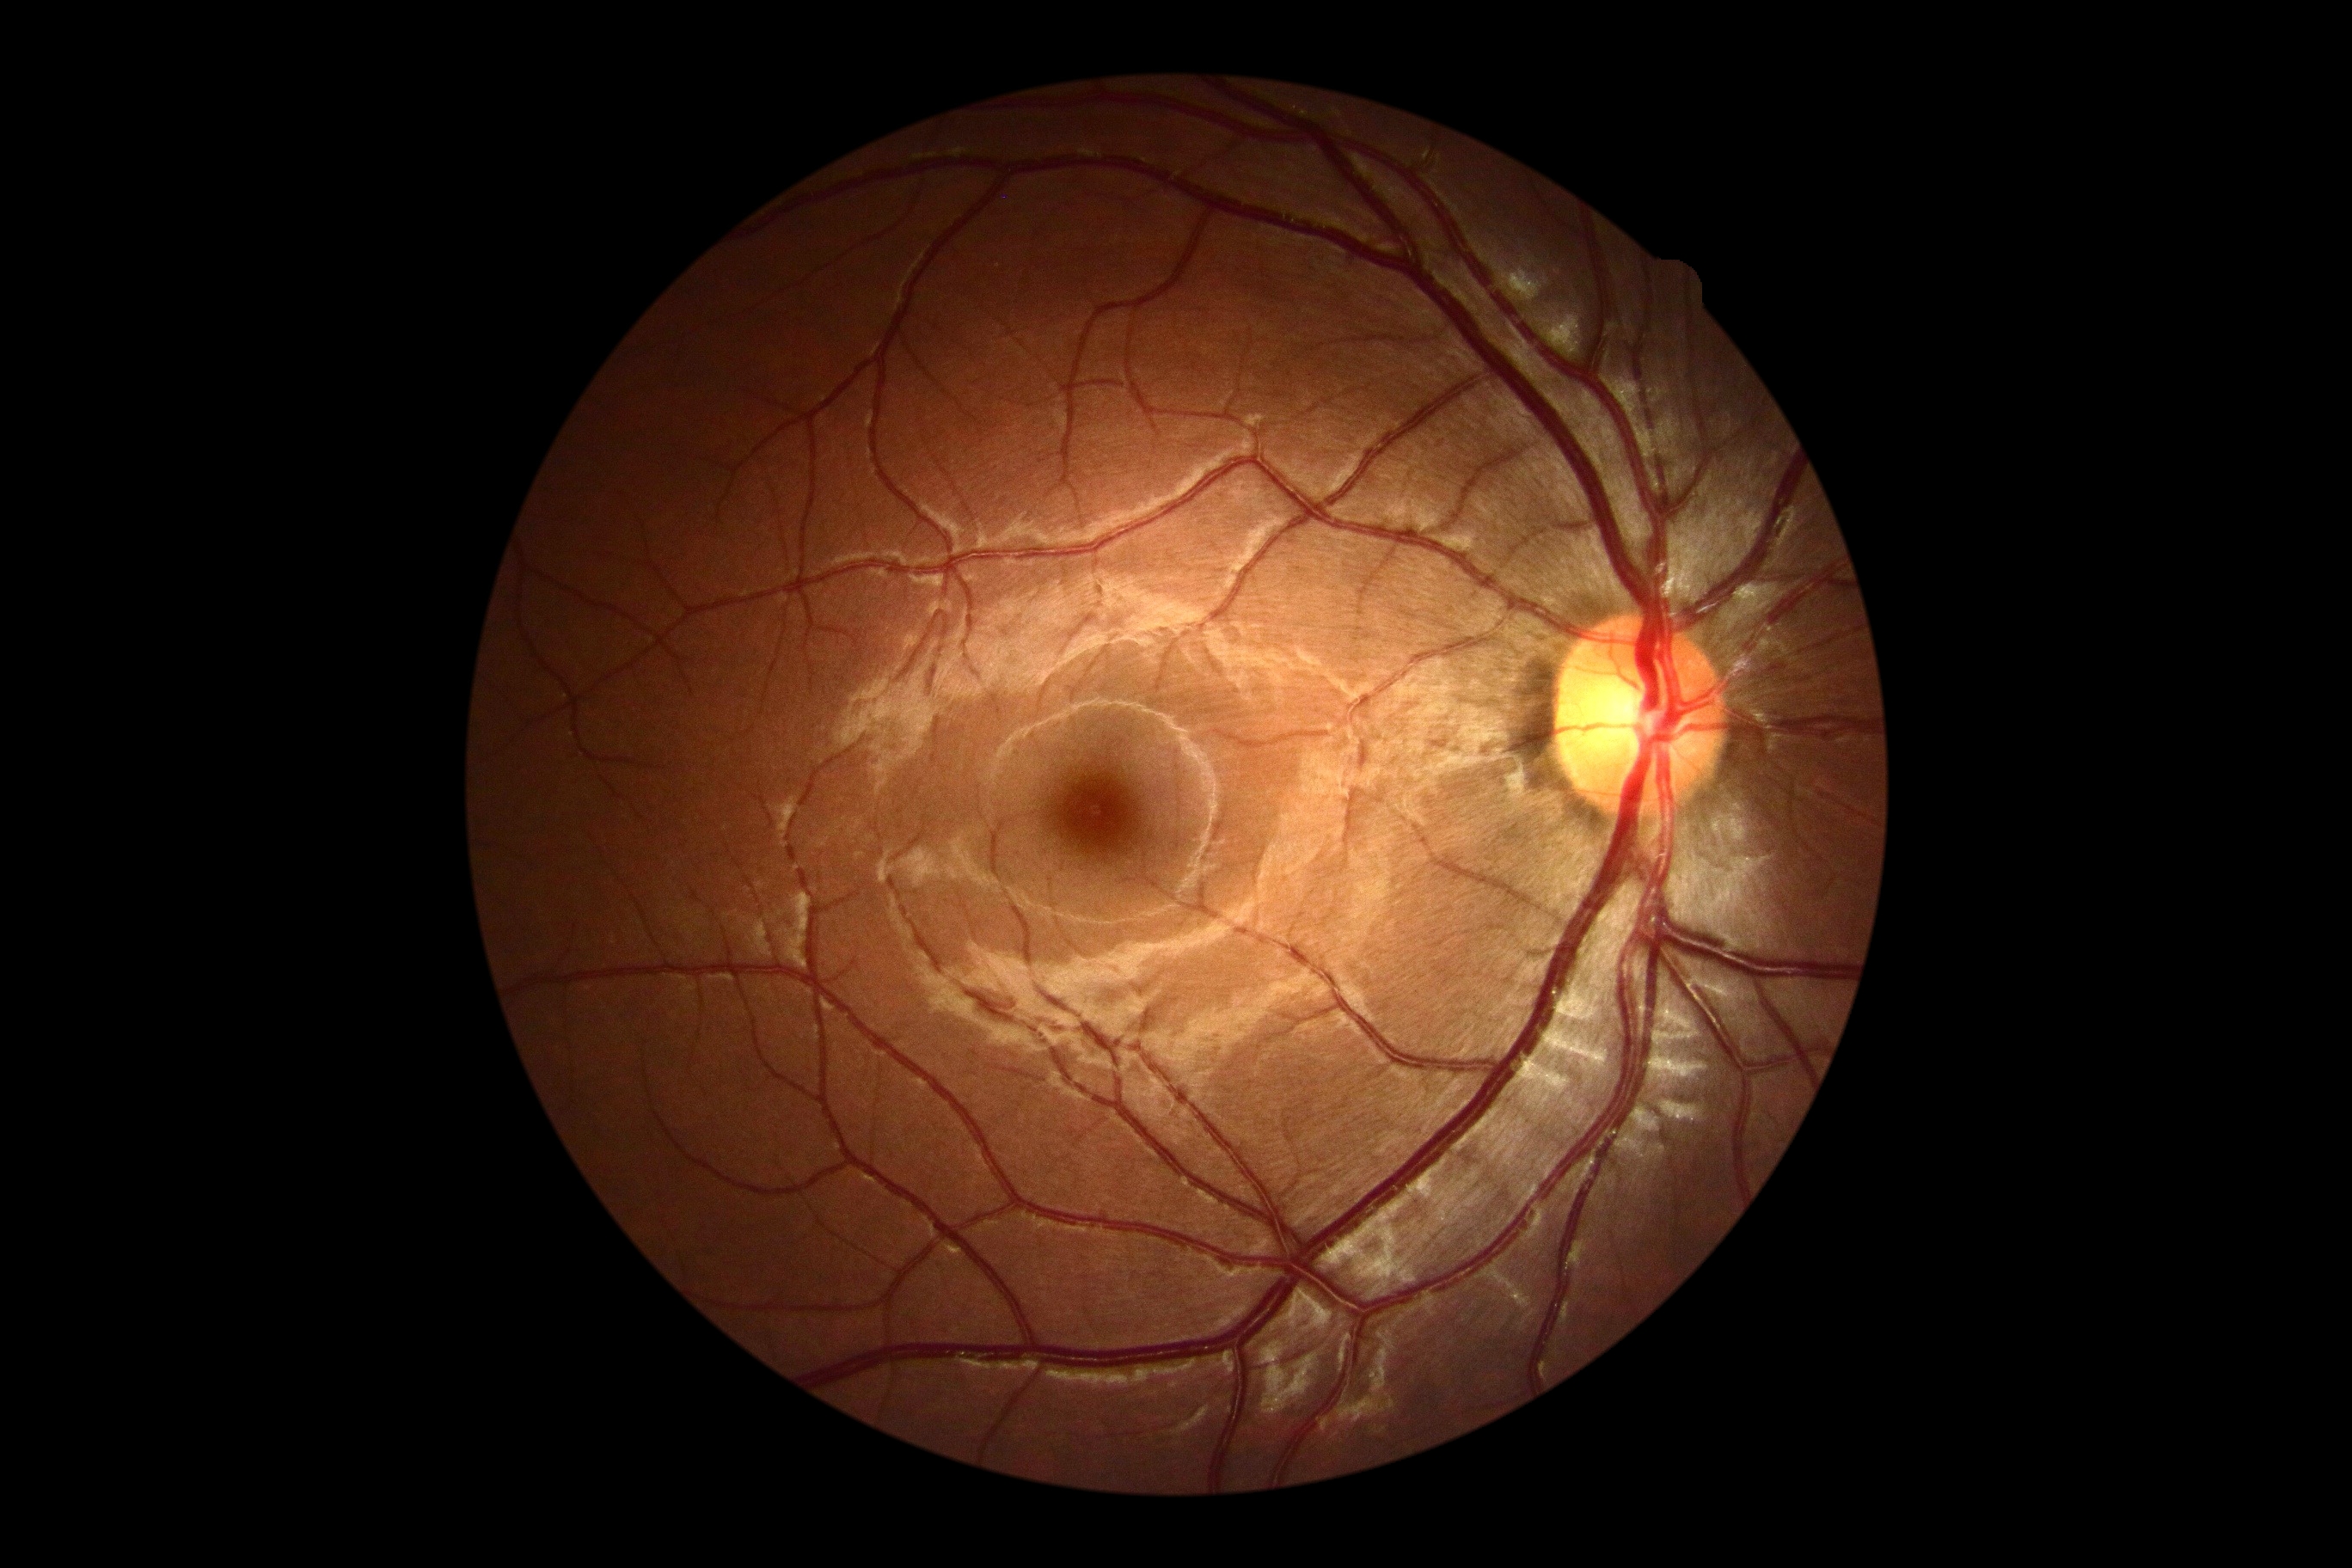

DR stage is grade 0 (no apparent retinopathy).